Color fundus photograph. FOV: 45 degrees. Image size 1932x1932:
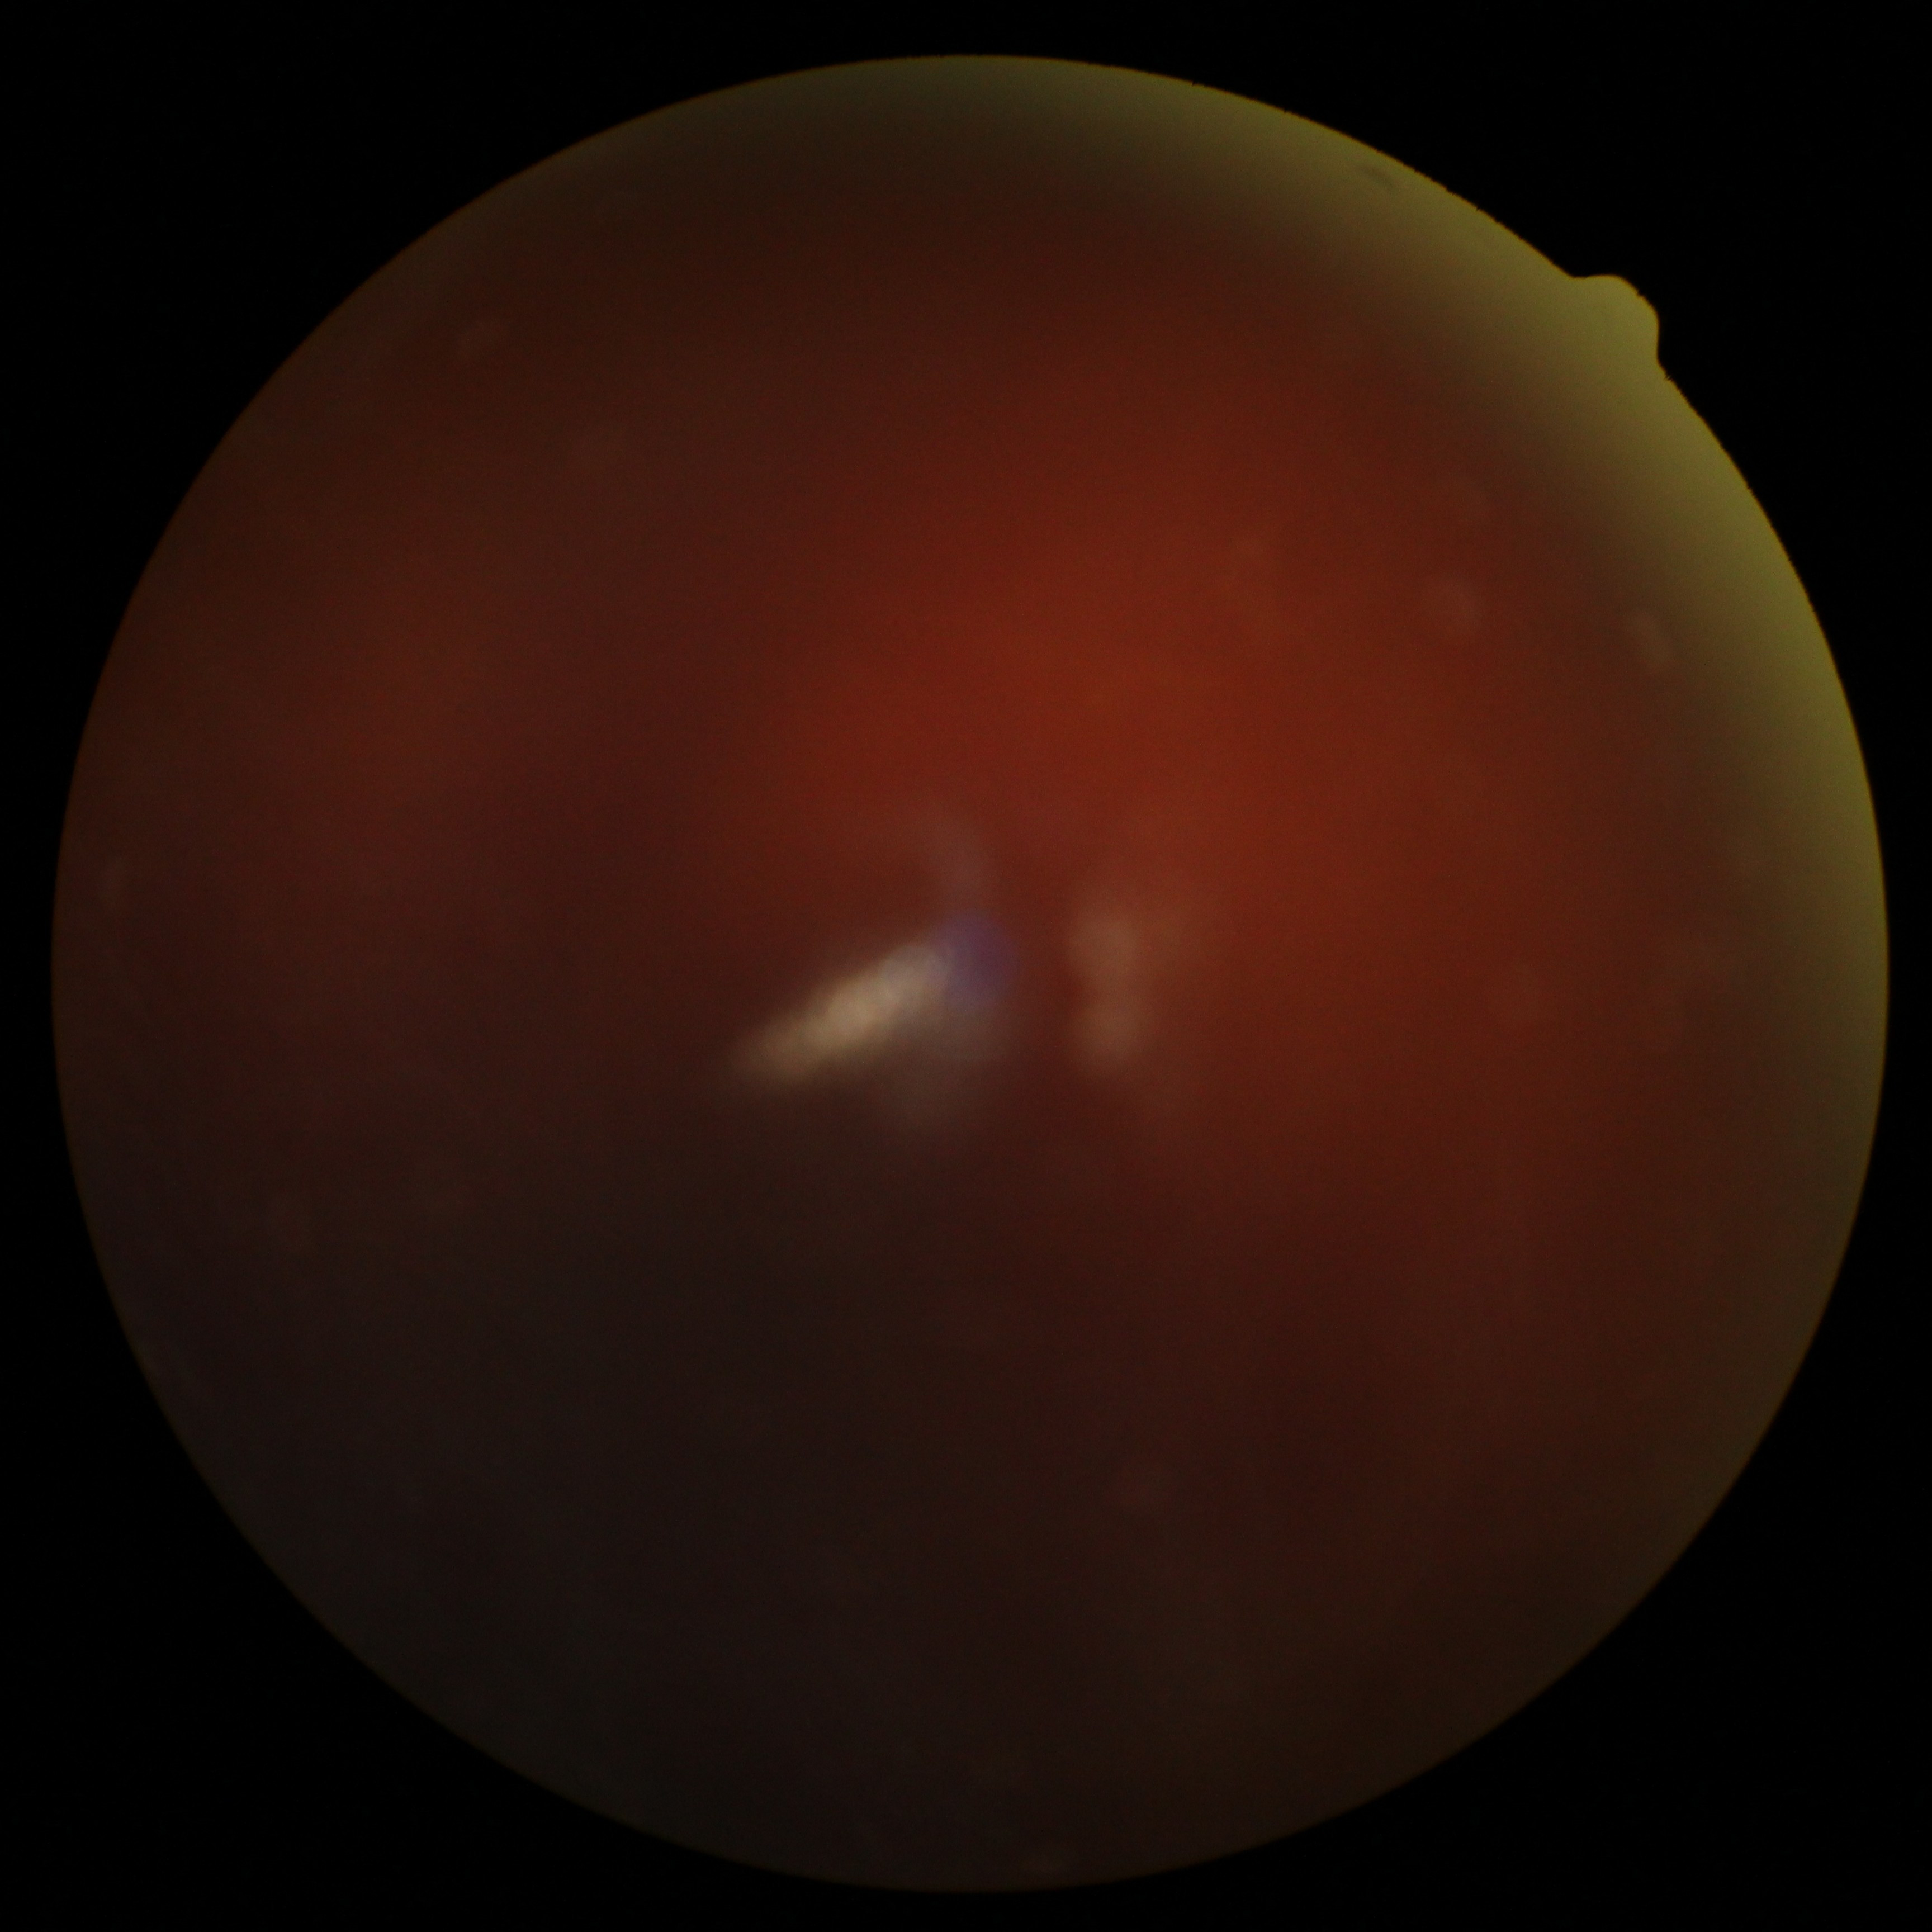

DR: ungradable due to poor image quality. Ungradable image — DR severity cannot be determined.